Pupil-dilated: 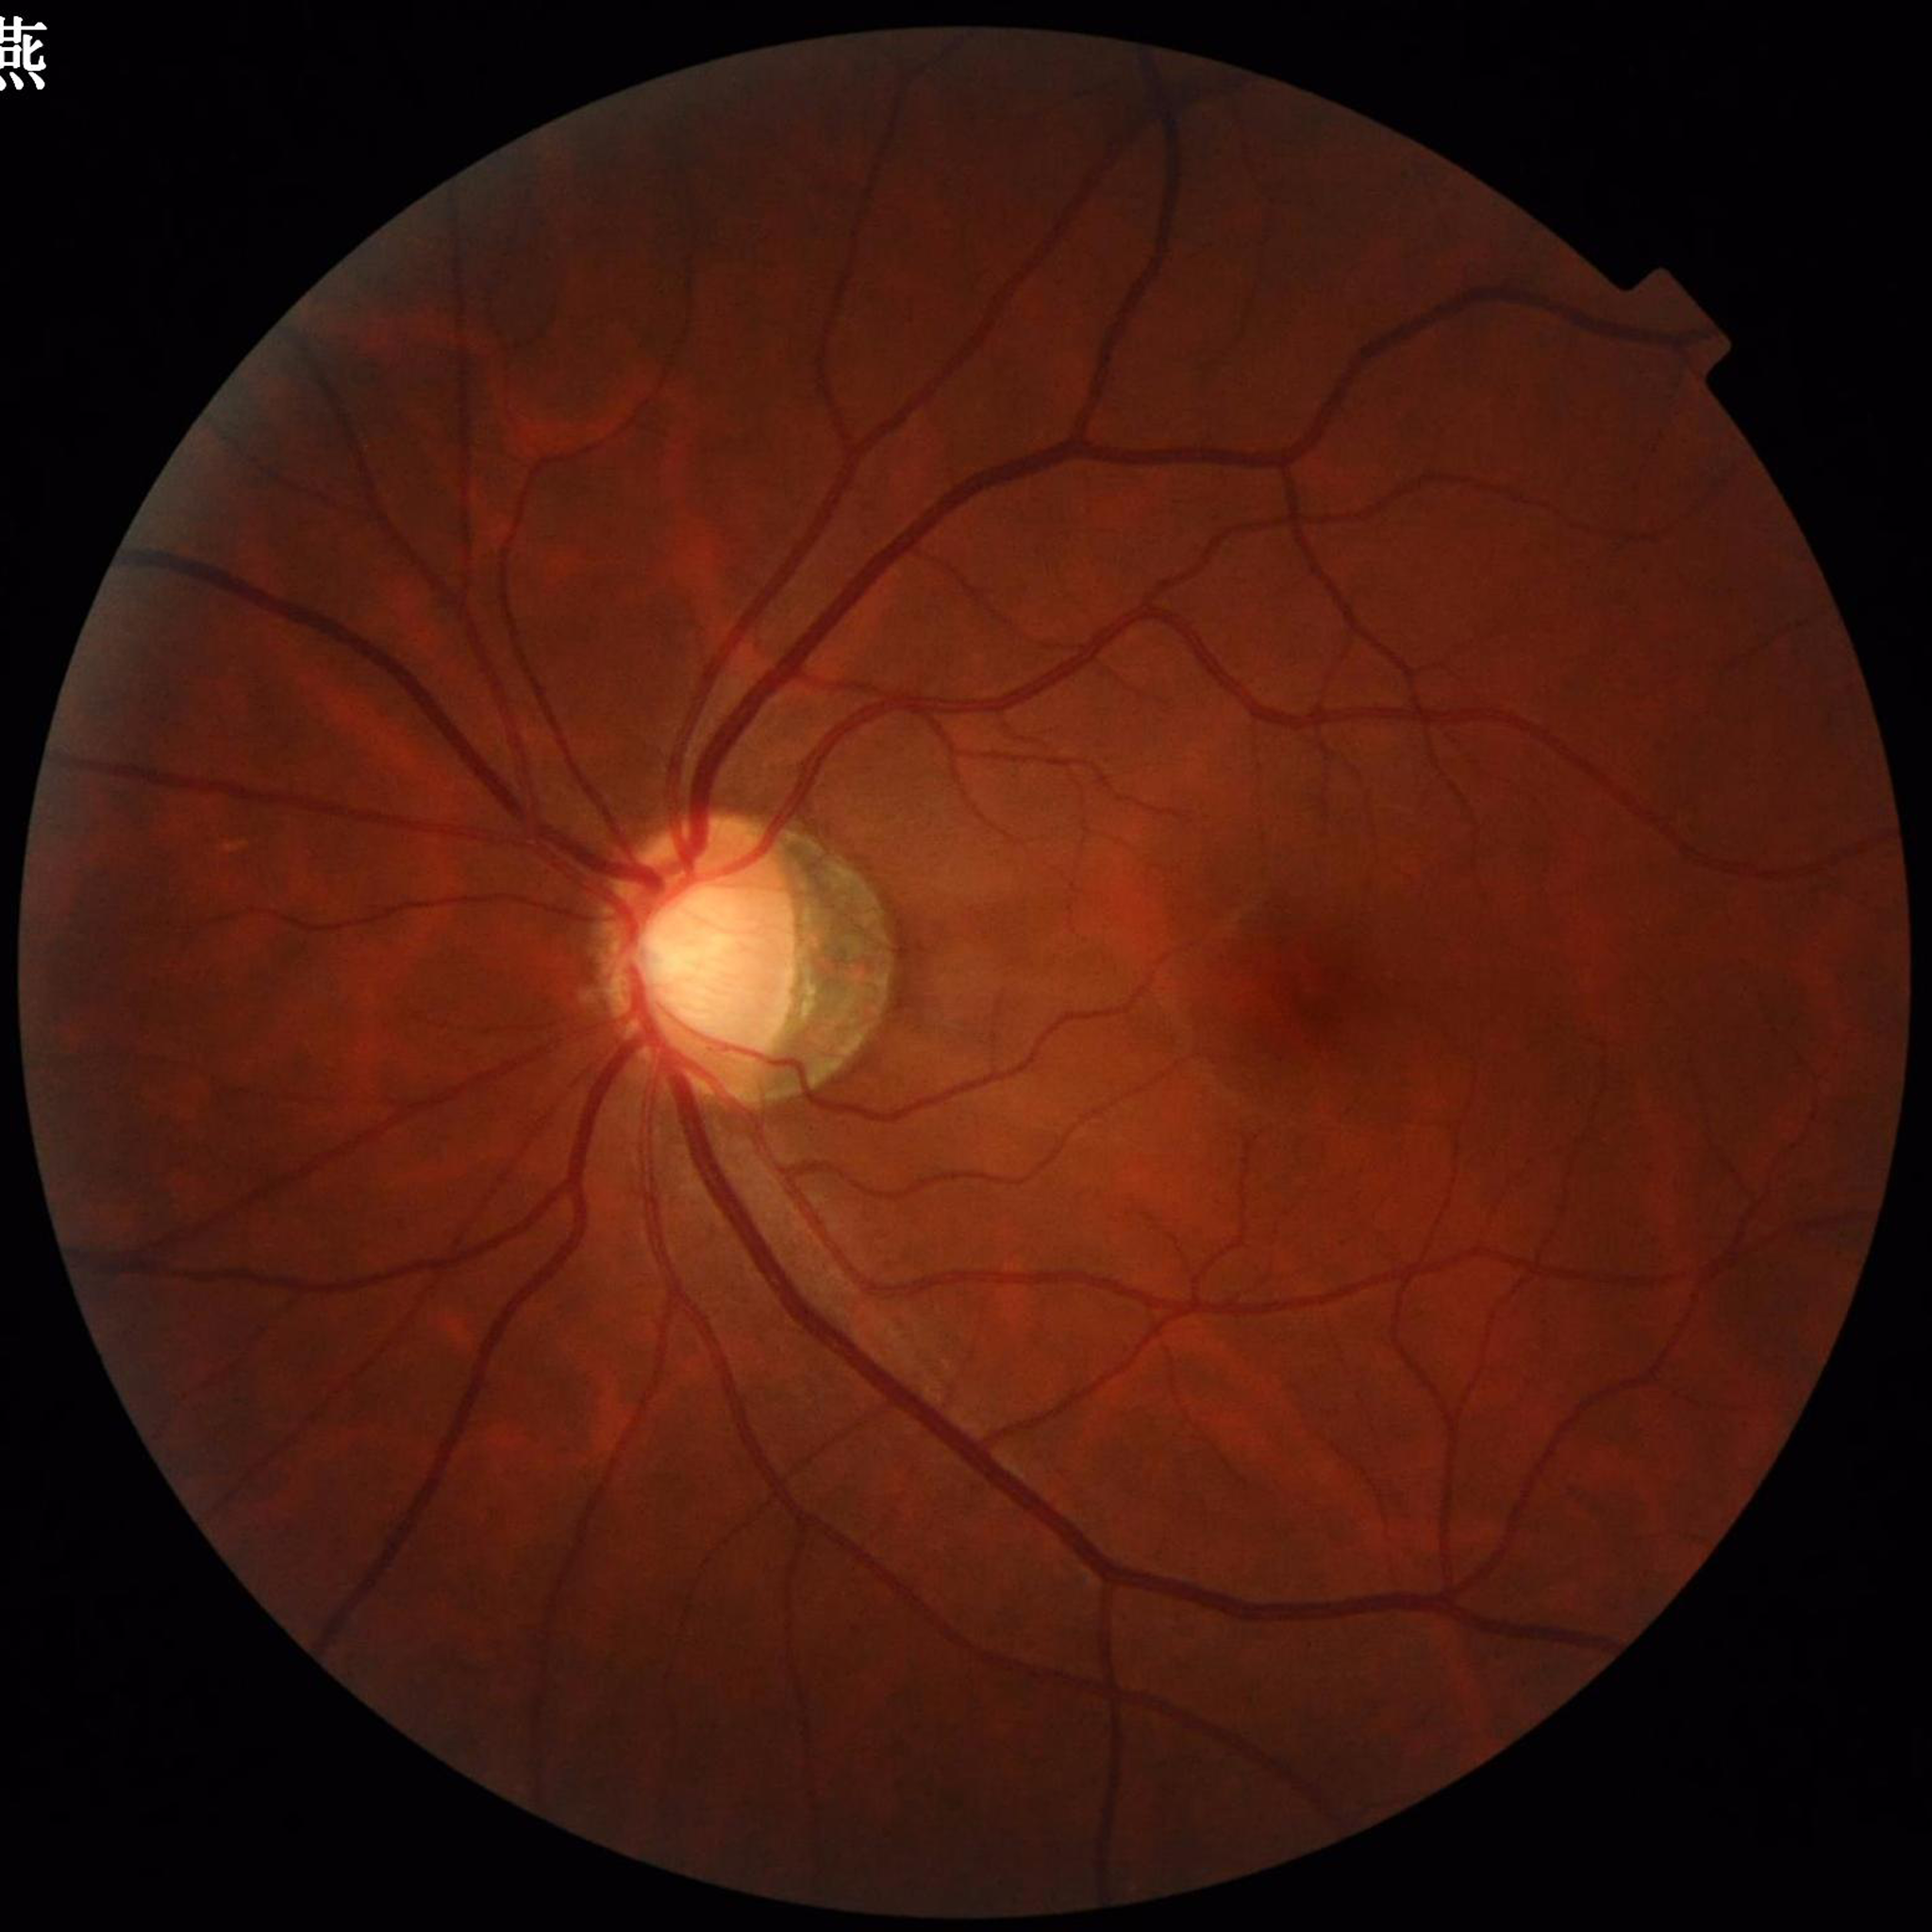

Impression: glaucoma
Quality assessment: satisfactory